1932 by 1910 pixels. 45° FOV — 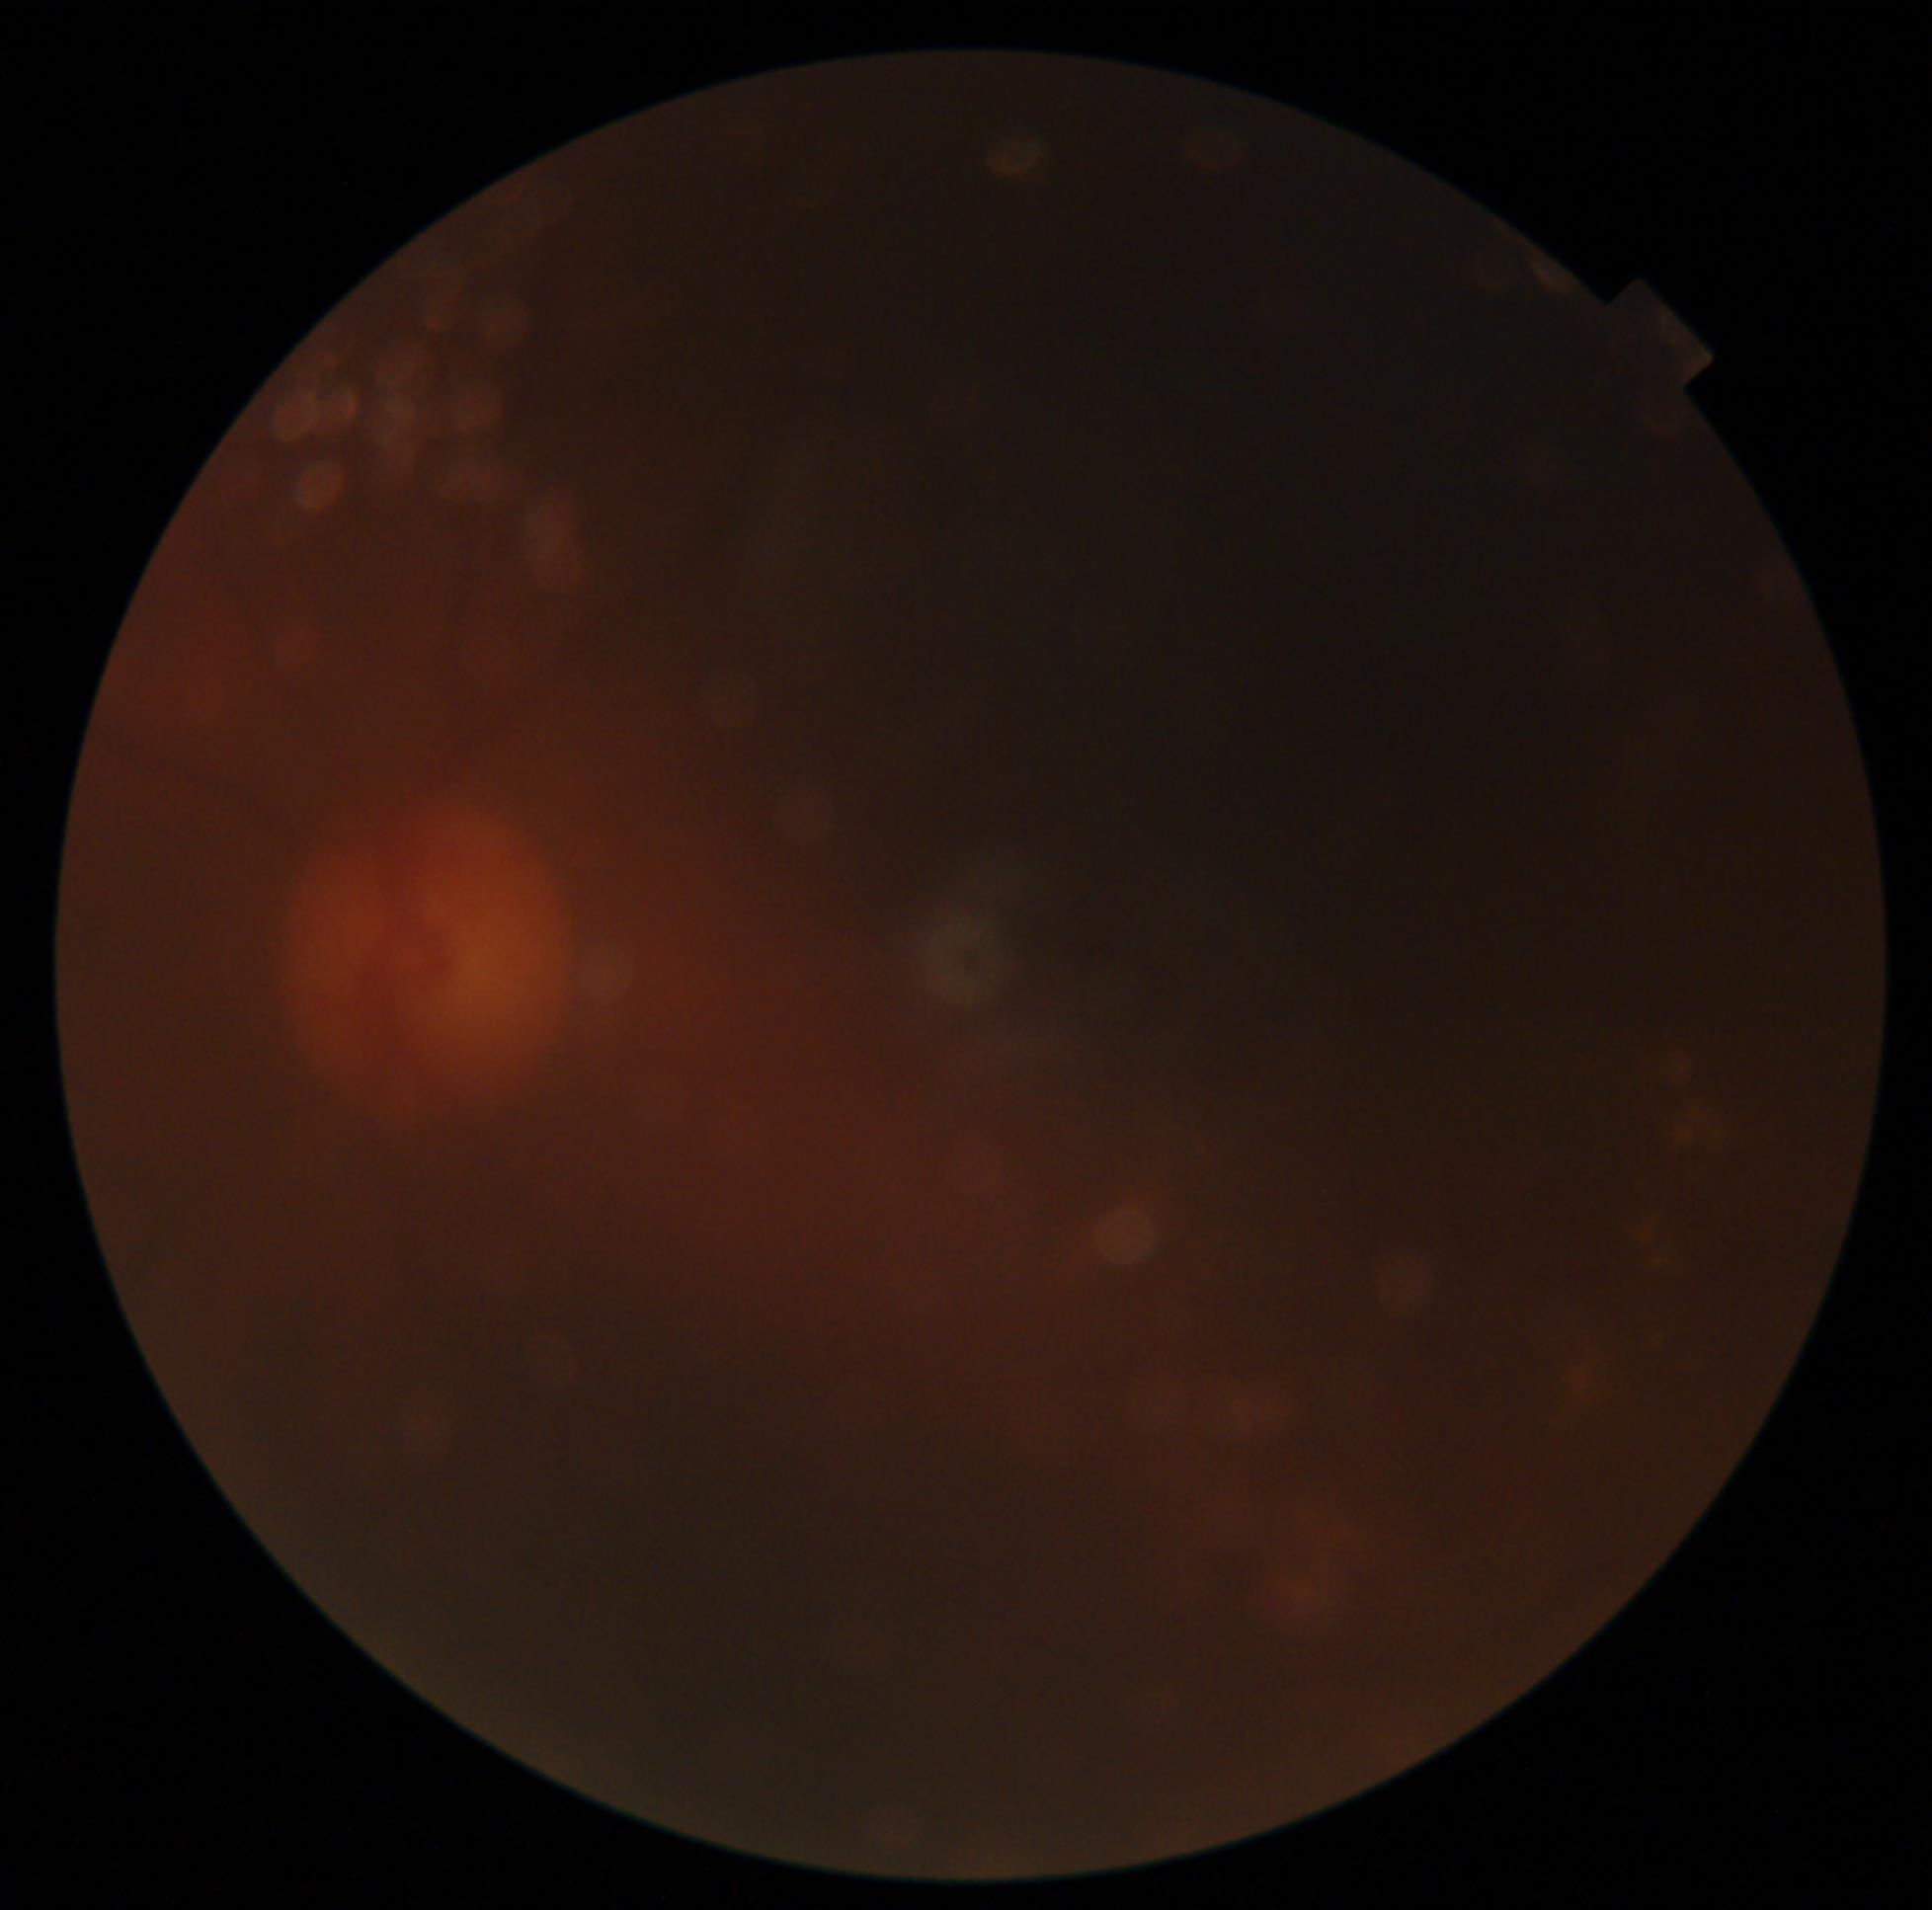

DR severity is ungradable due to poor image quality.